Fundus photo
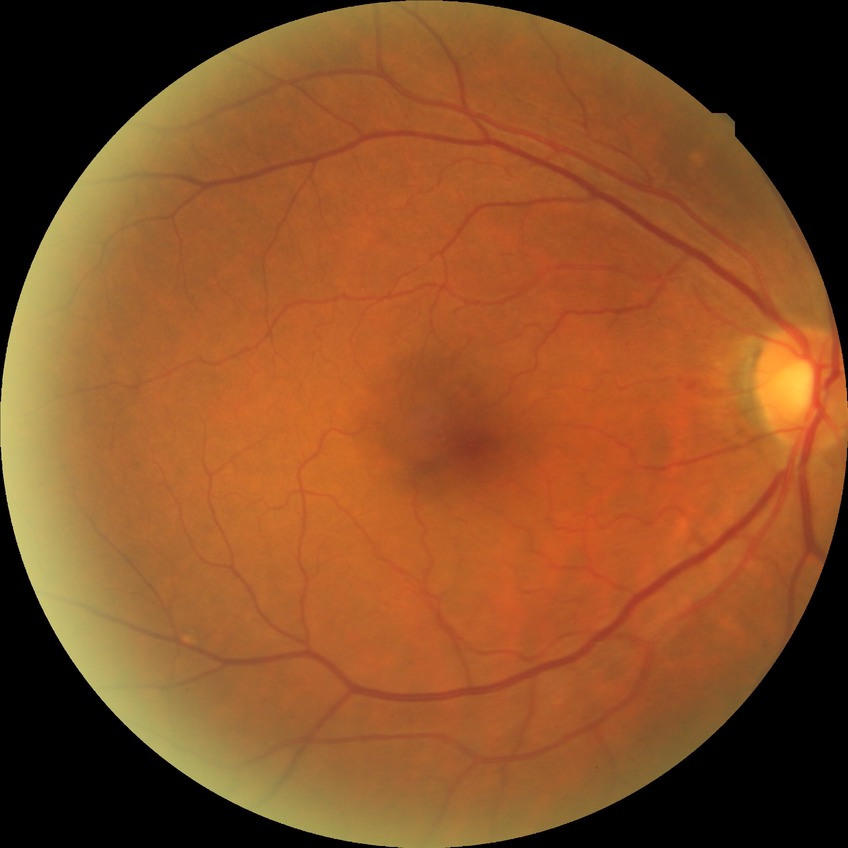

retinopathy stage: no diabetic retinopathy